640x480px; pediatric wide-field fundus photograph
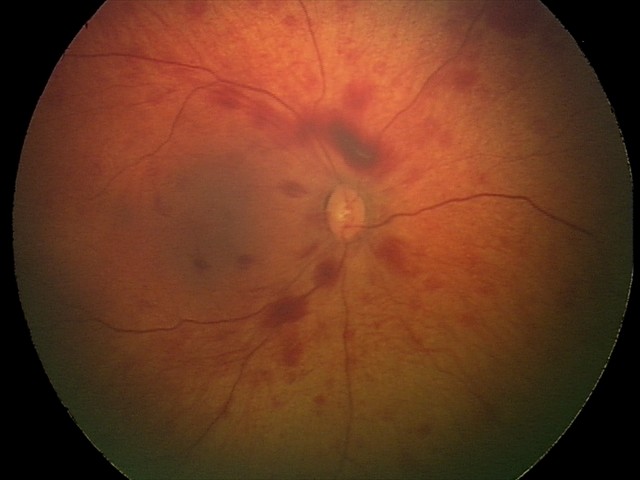 Examination diagnosed as retinal hemorrhages.